Color fundus image.
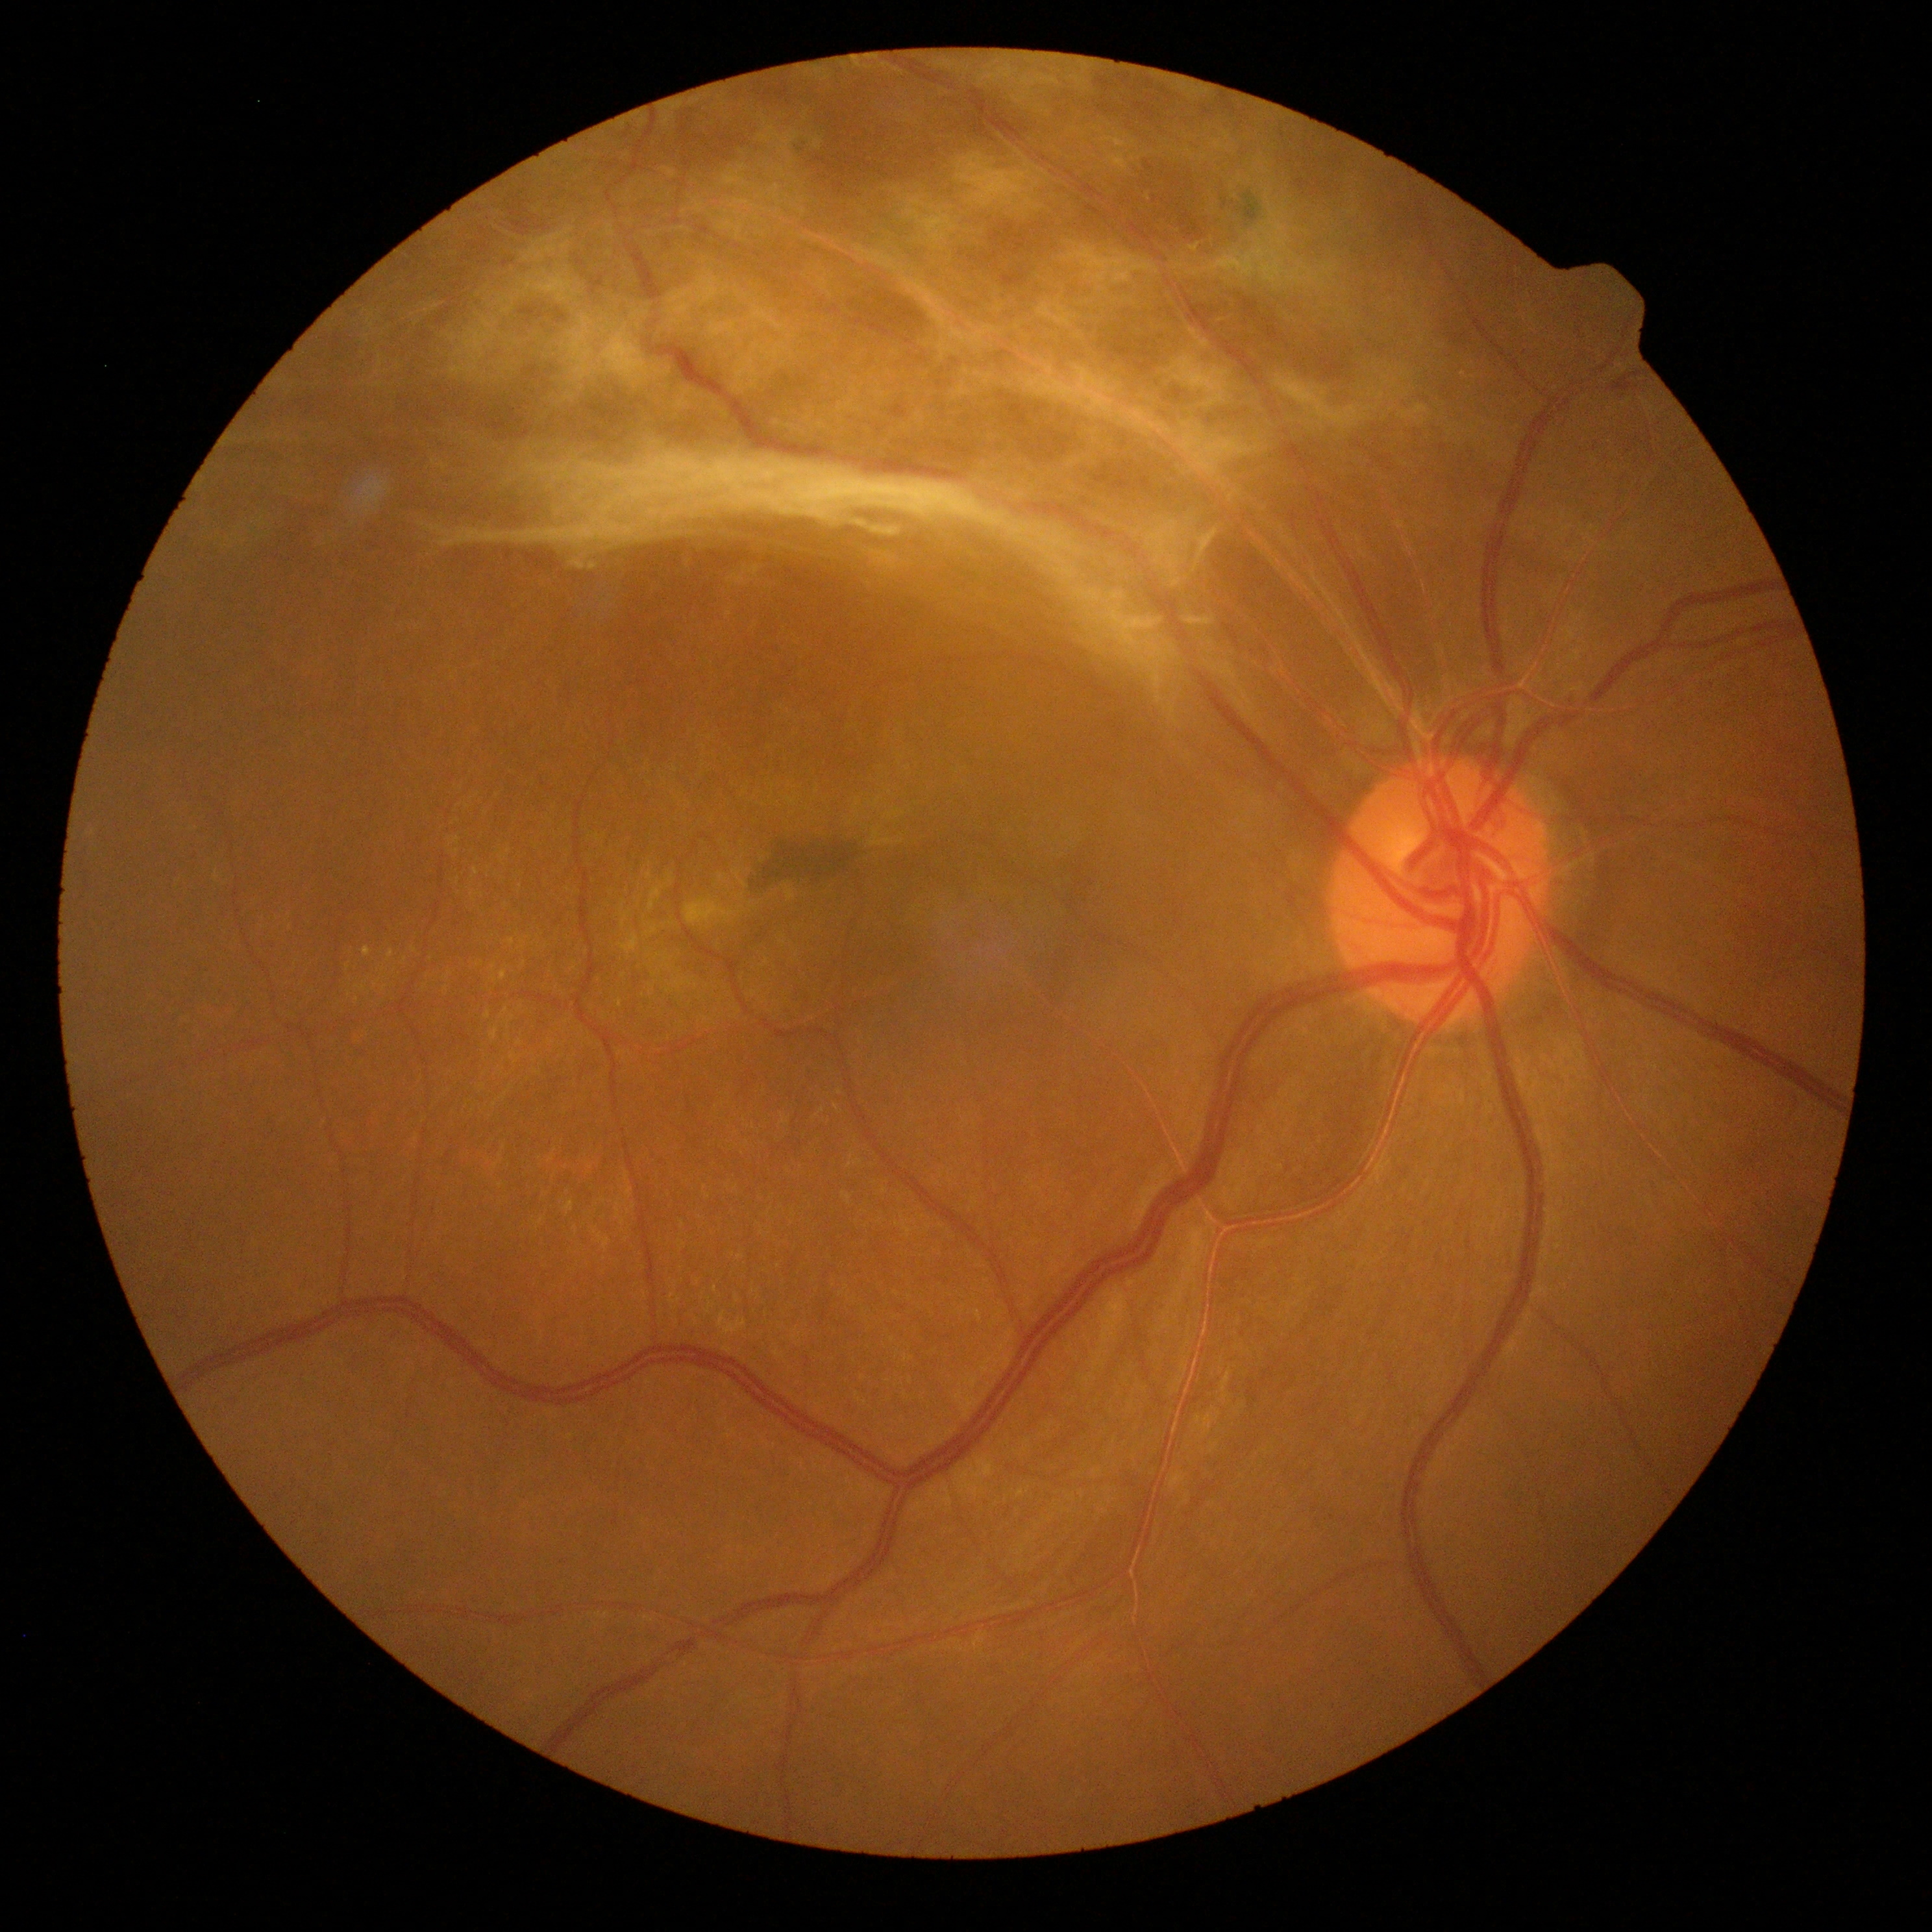 DR class: proliferative diabetic retinopathy; retinopathy: grade 4 (PDR).